Color fundus photograph, acquired with a NIDEK AFC-230: 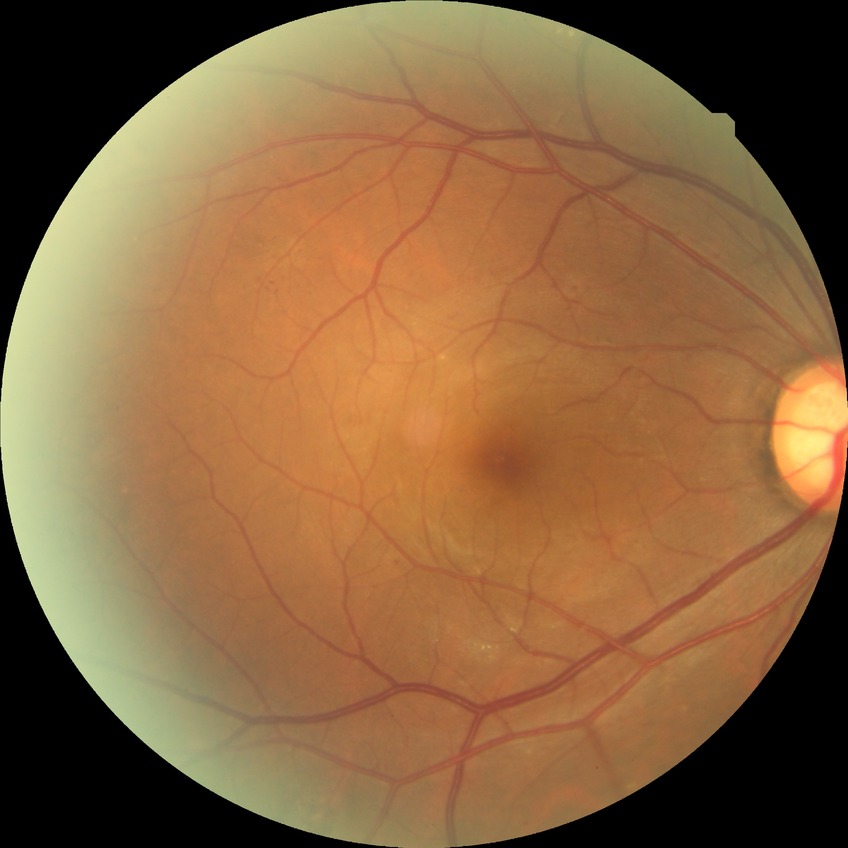
• diabetic retinopathy (DR): simple diabetic retinopathy (SDR)